Fundus photo · 45° FOV — 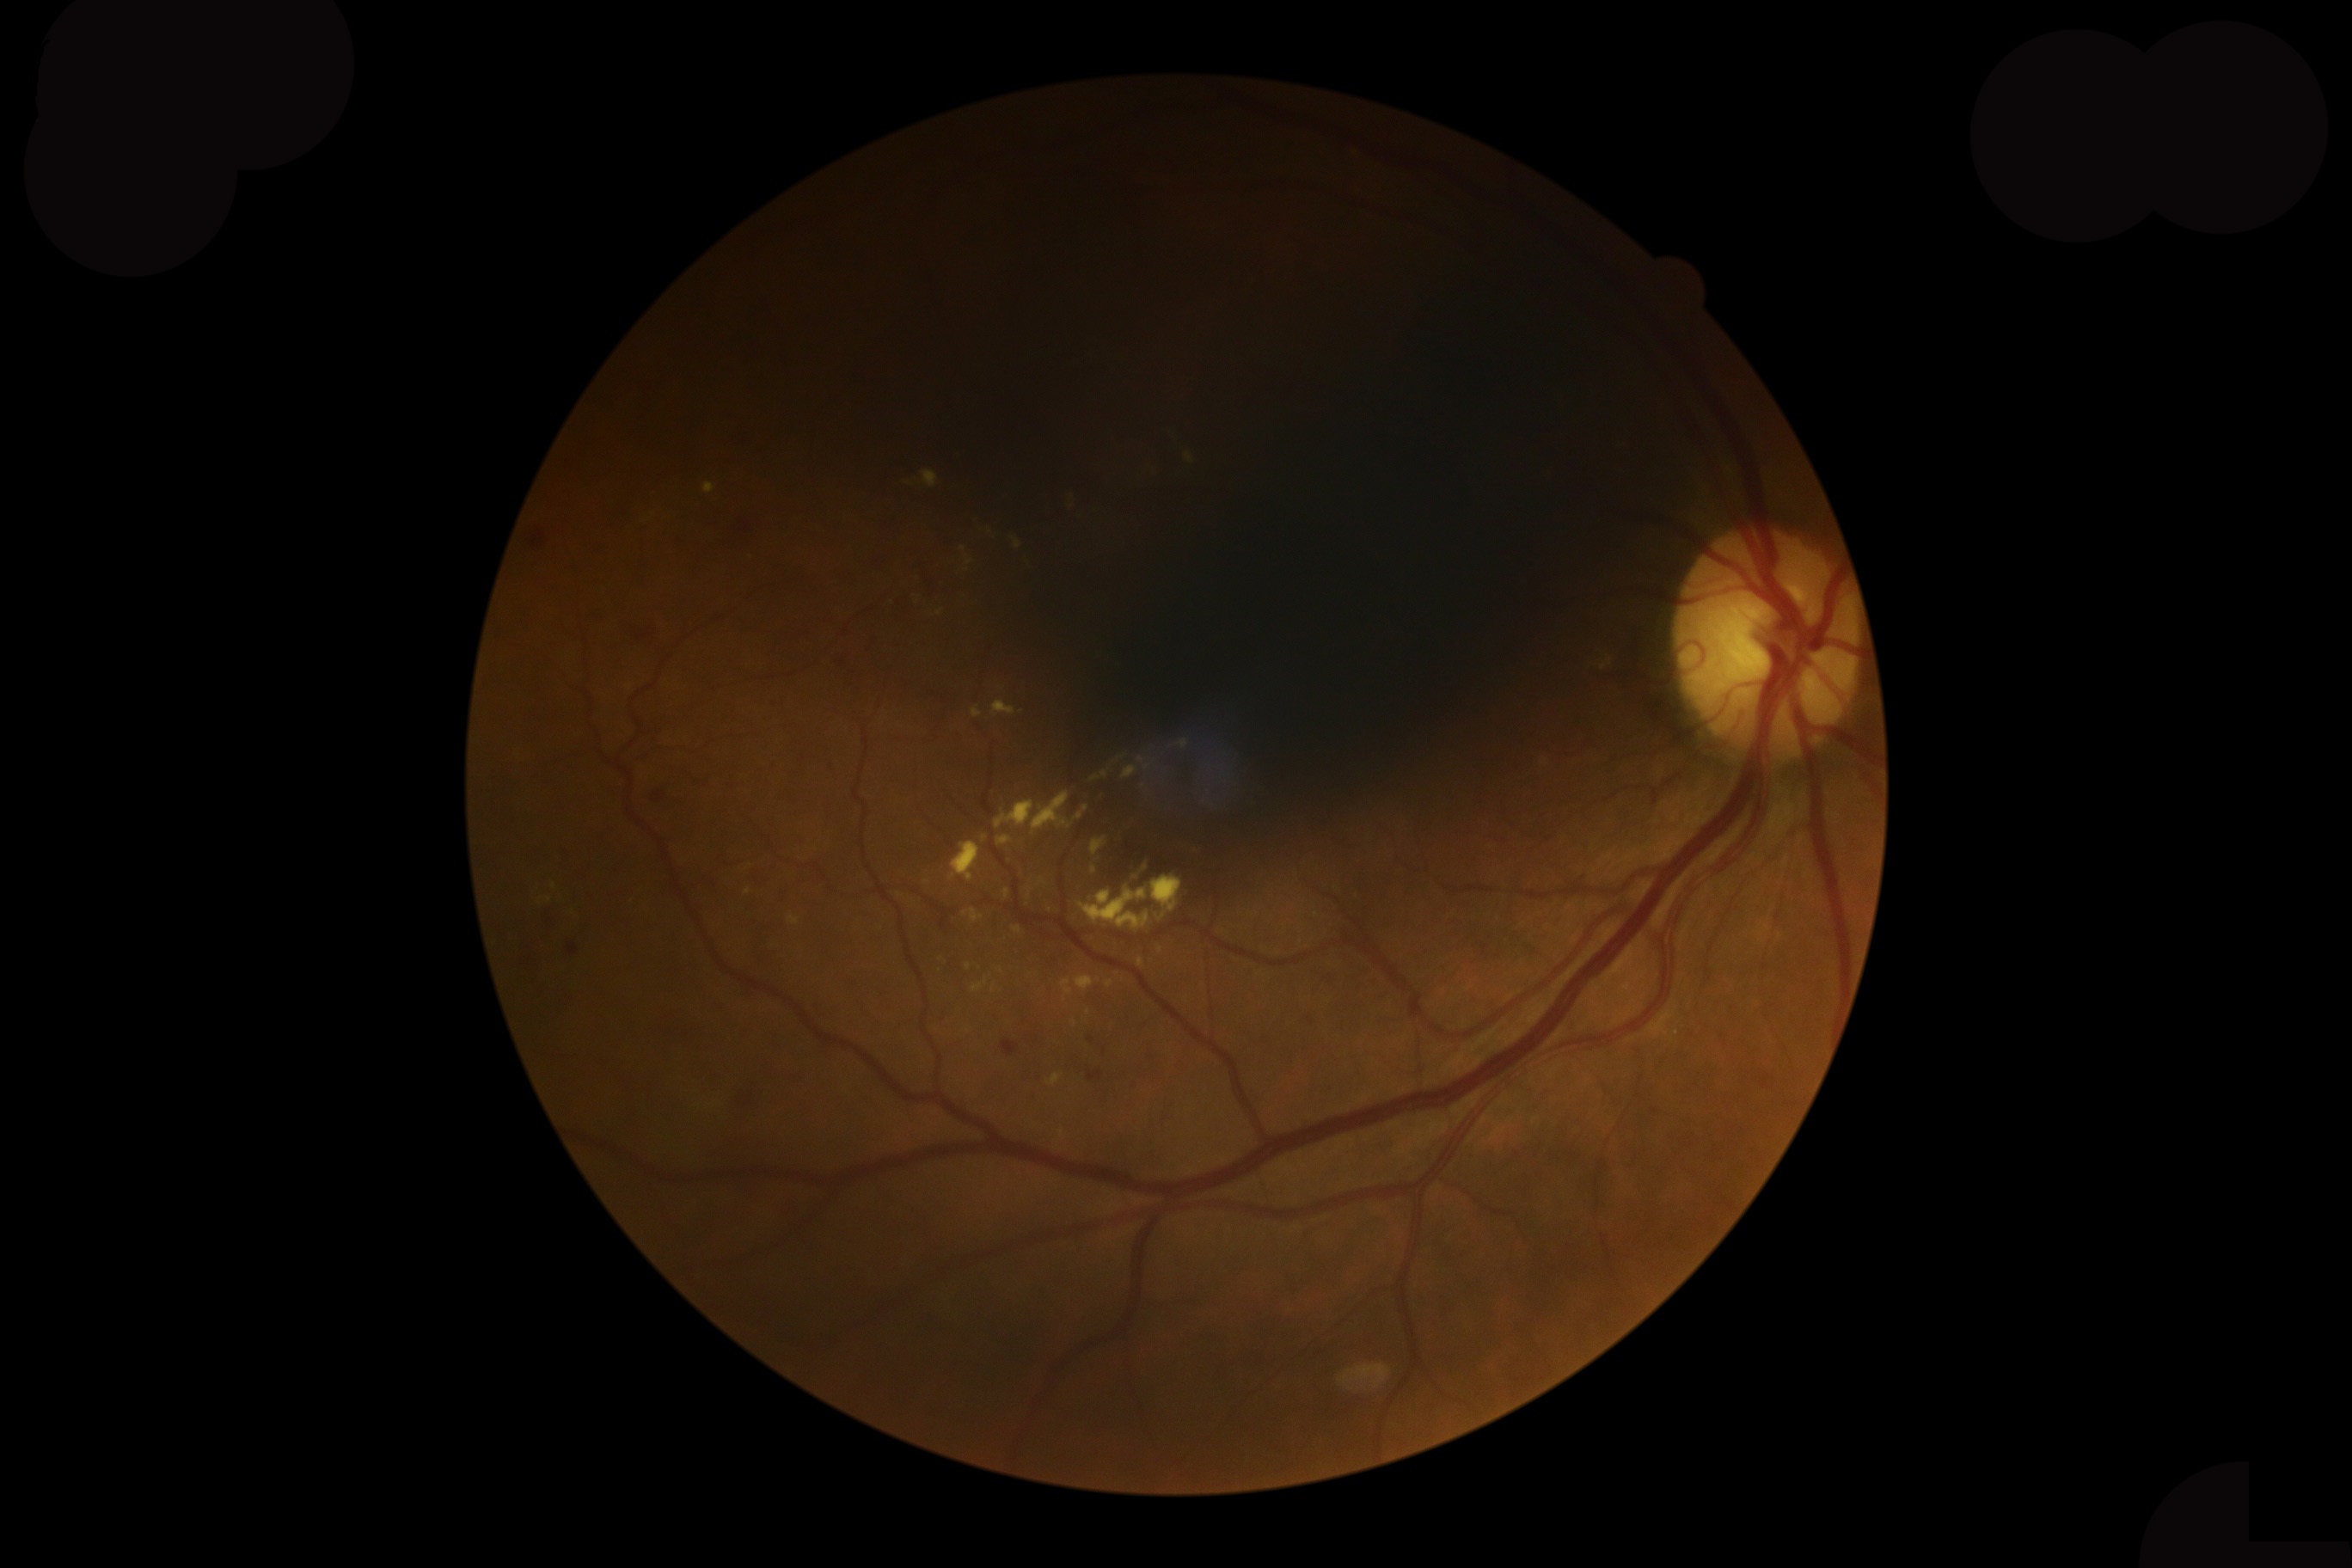

DR: moderate non-proliferative diabetic retinopathy (grade 2) — more than just microaneurysms but less than severe NPDR. Disease class: non-proliferative diabetic retinopathy.